Pediatric retinal photograph (wide-field). Camera: Clarity RetCam 3 (130° FOV): 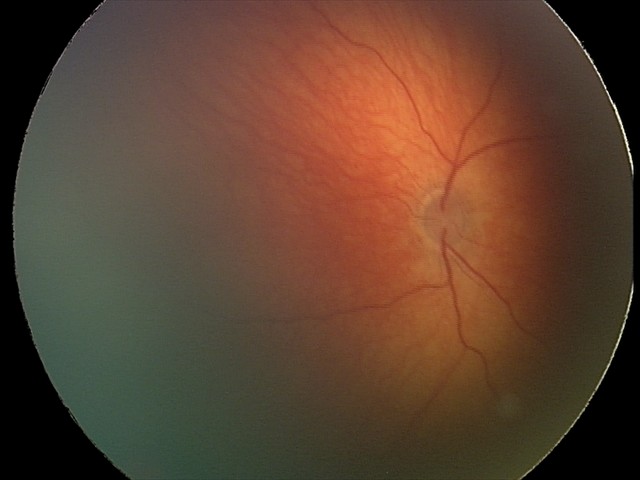
Screening series with retinal hemorrhages.